Davis DR grading:
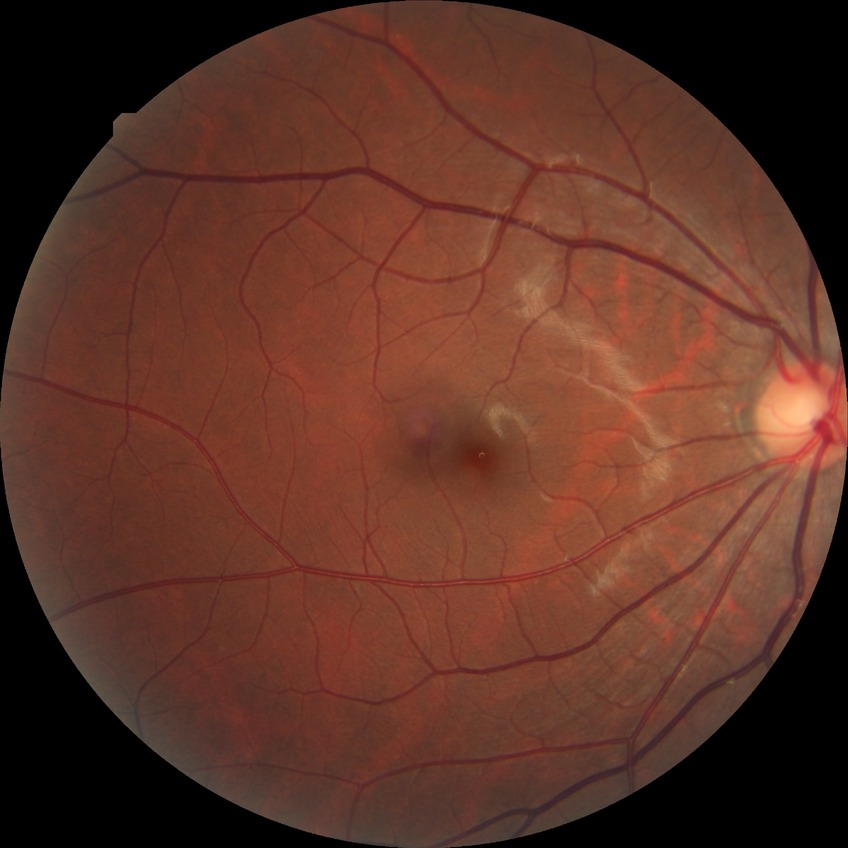
diabetic retinopathy (DR): no diabetic retinopathy (NDR).